2228 by 1652 pixels:
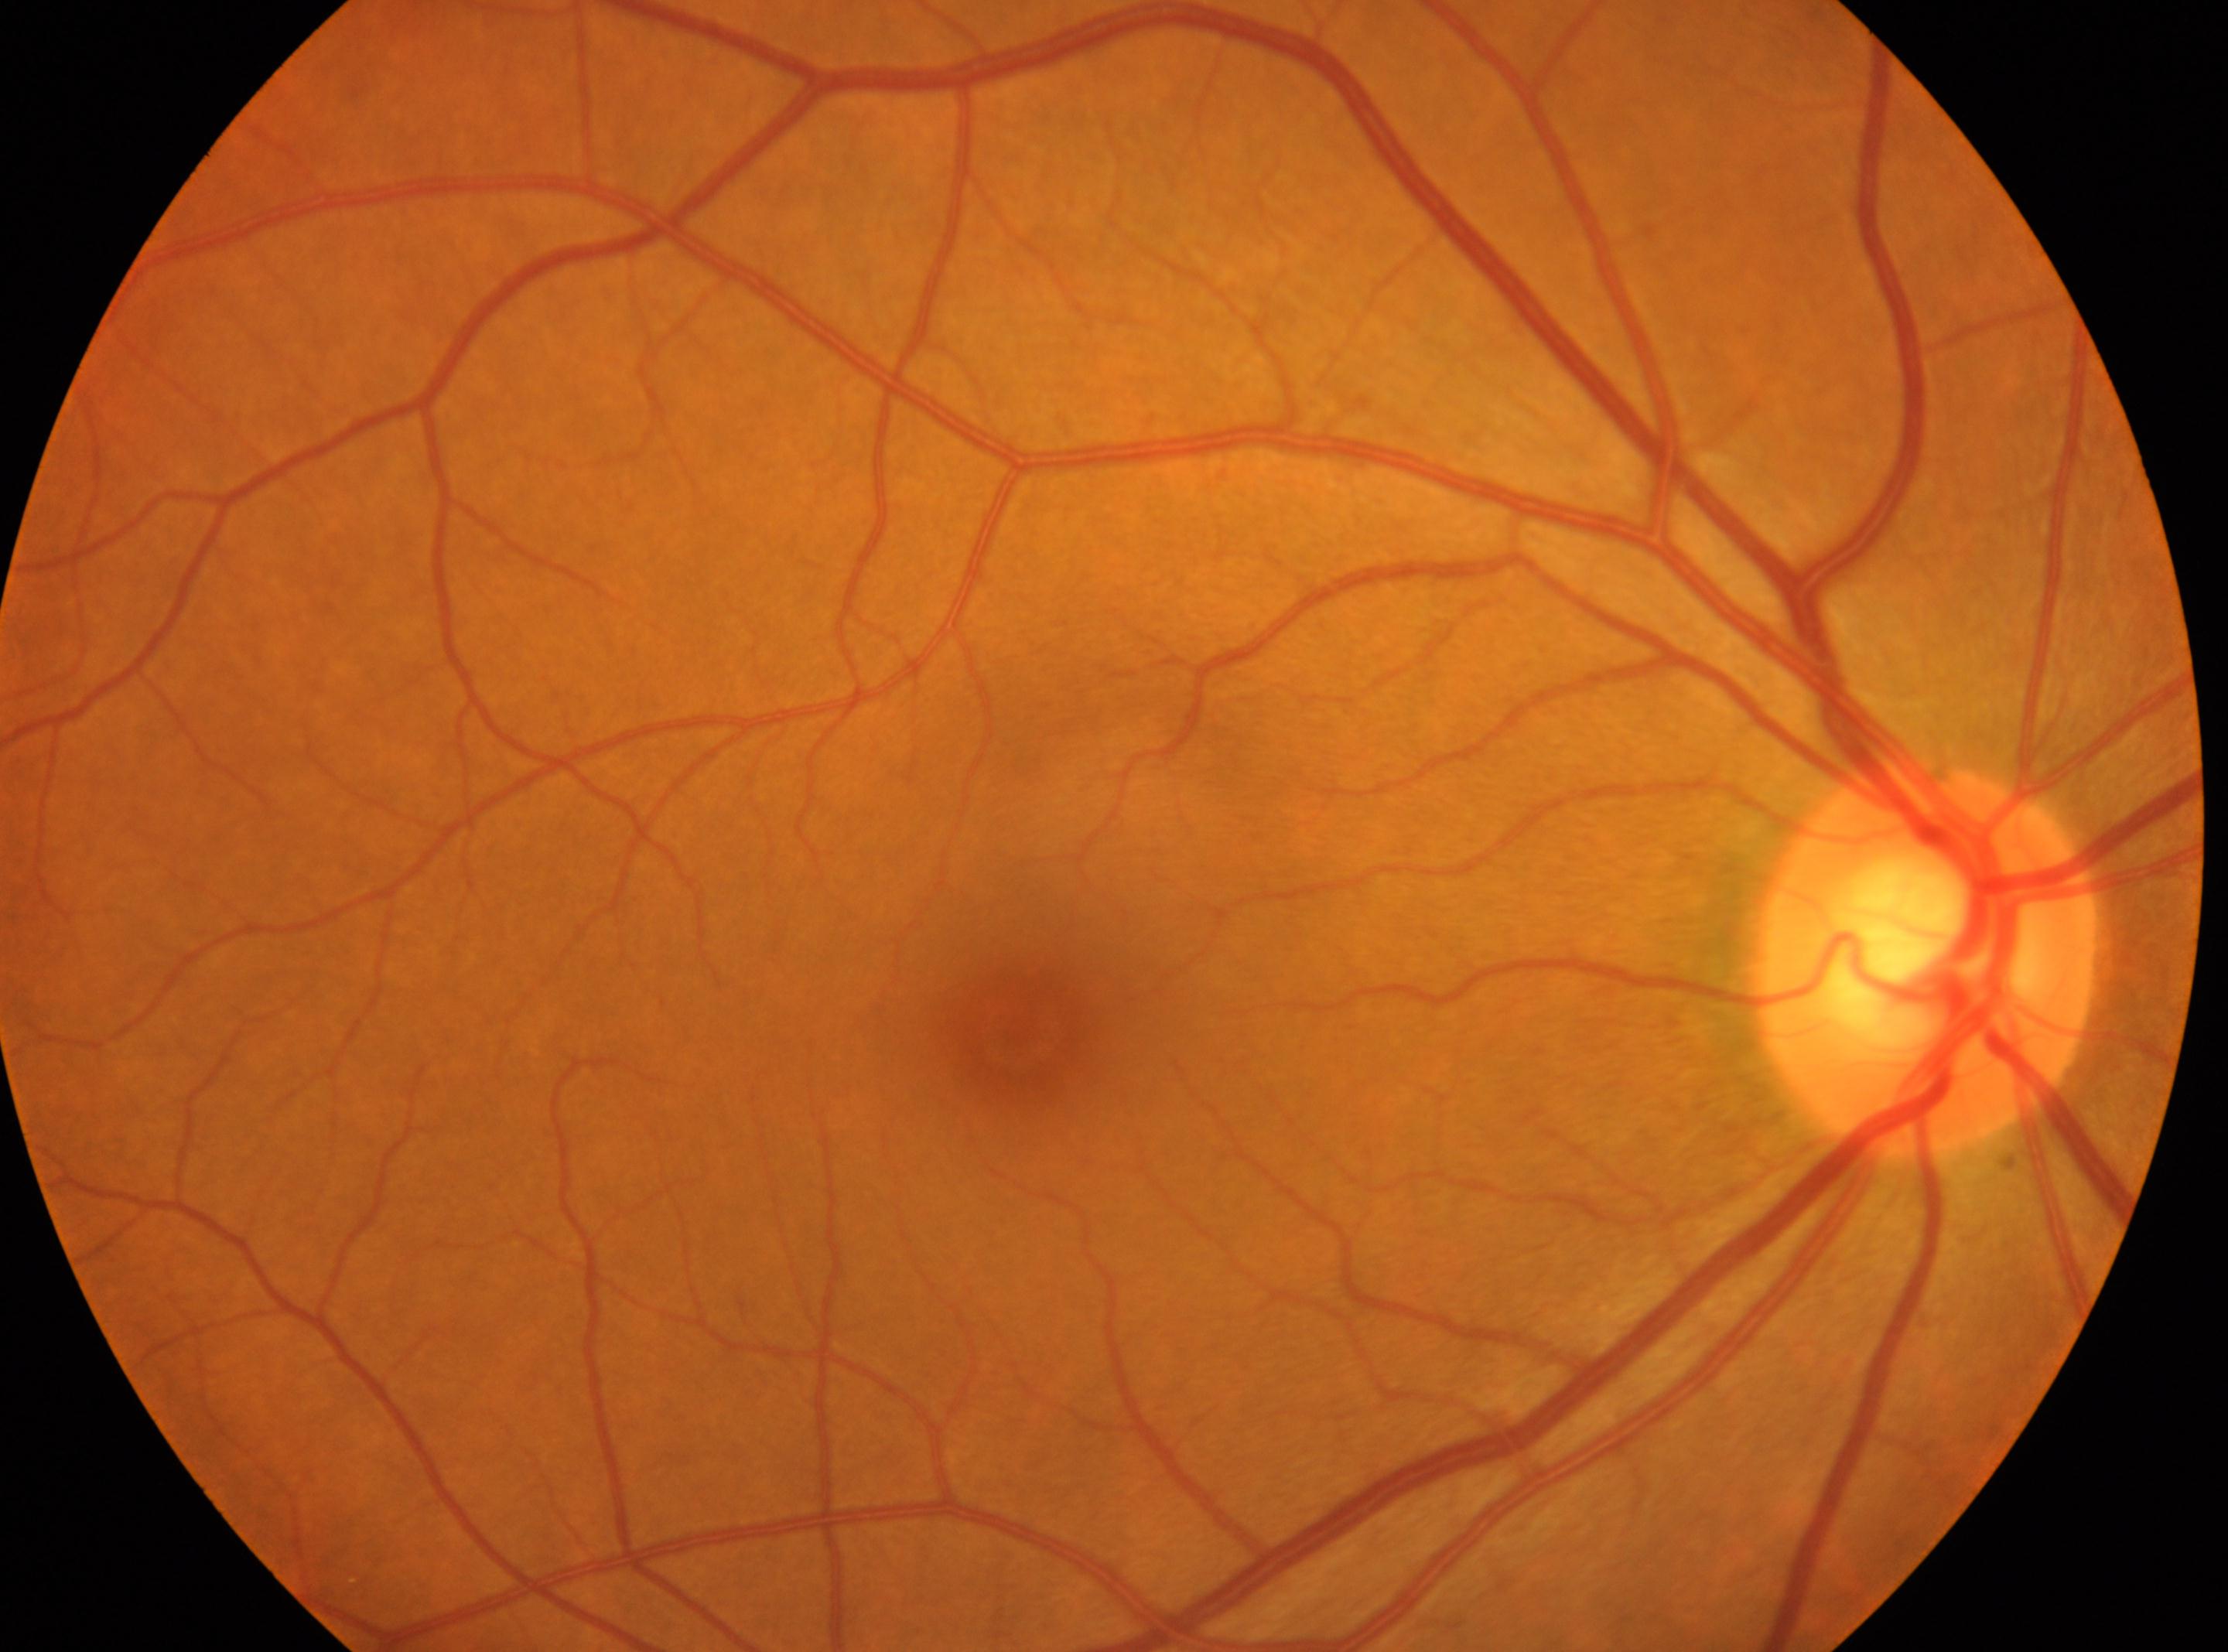 DR impression: No signs of diabetic retinopathy; fovea center: [1024, 1033]; optic disk: [1926, 957]; DR grade: 0; laterality: oculus dexter.